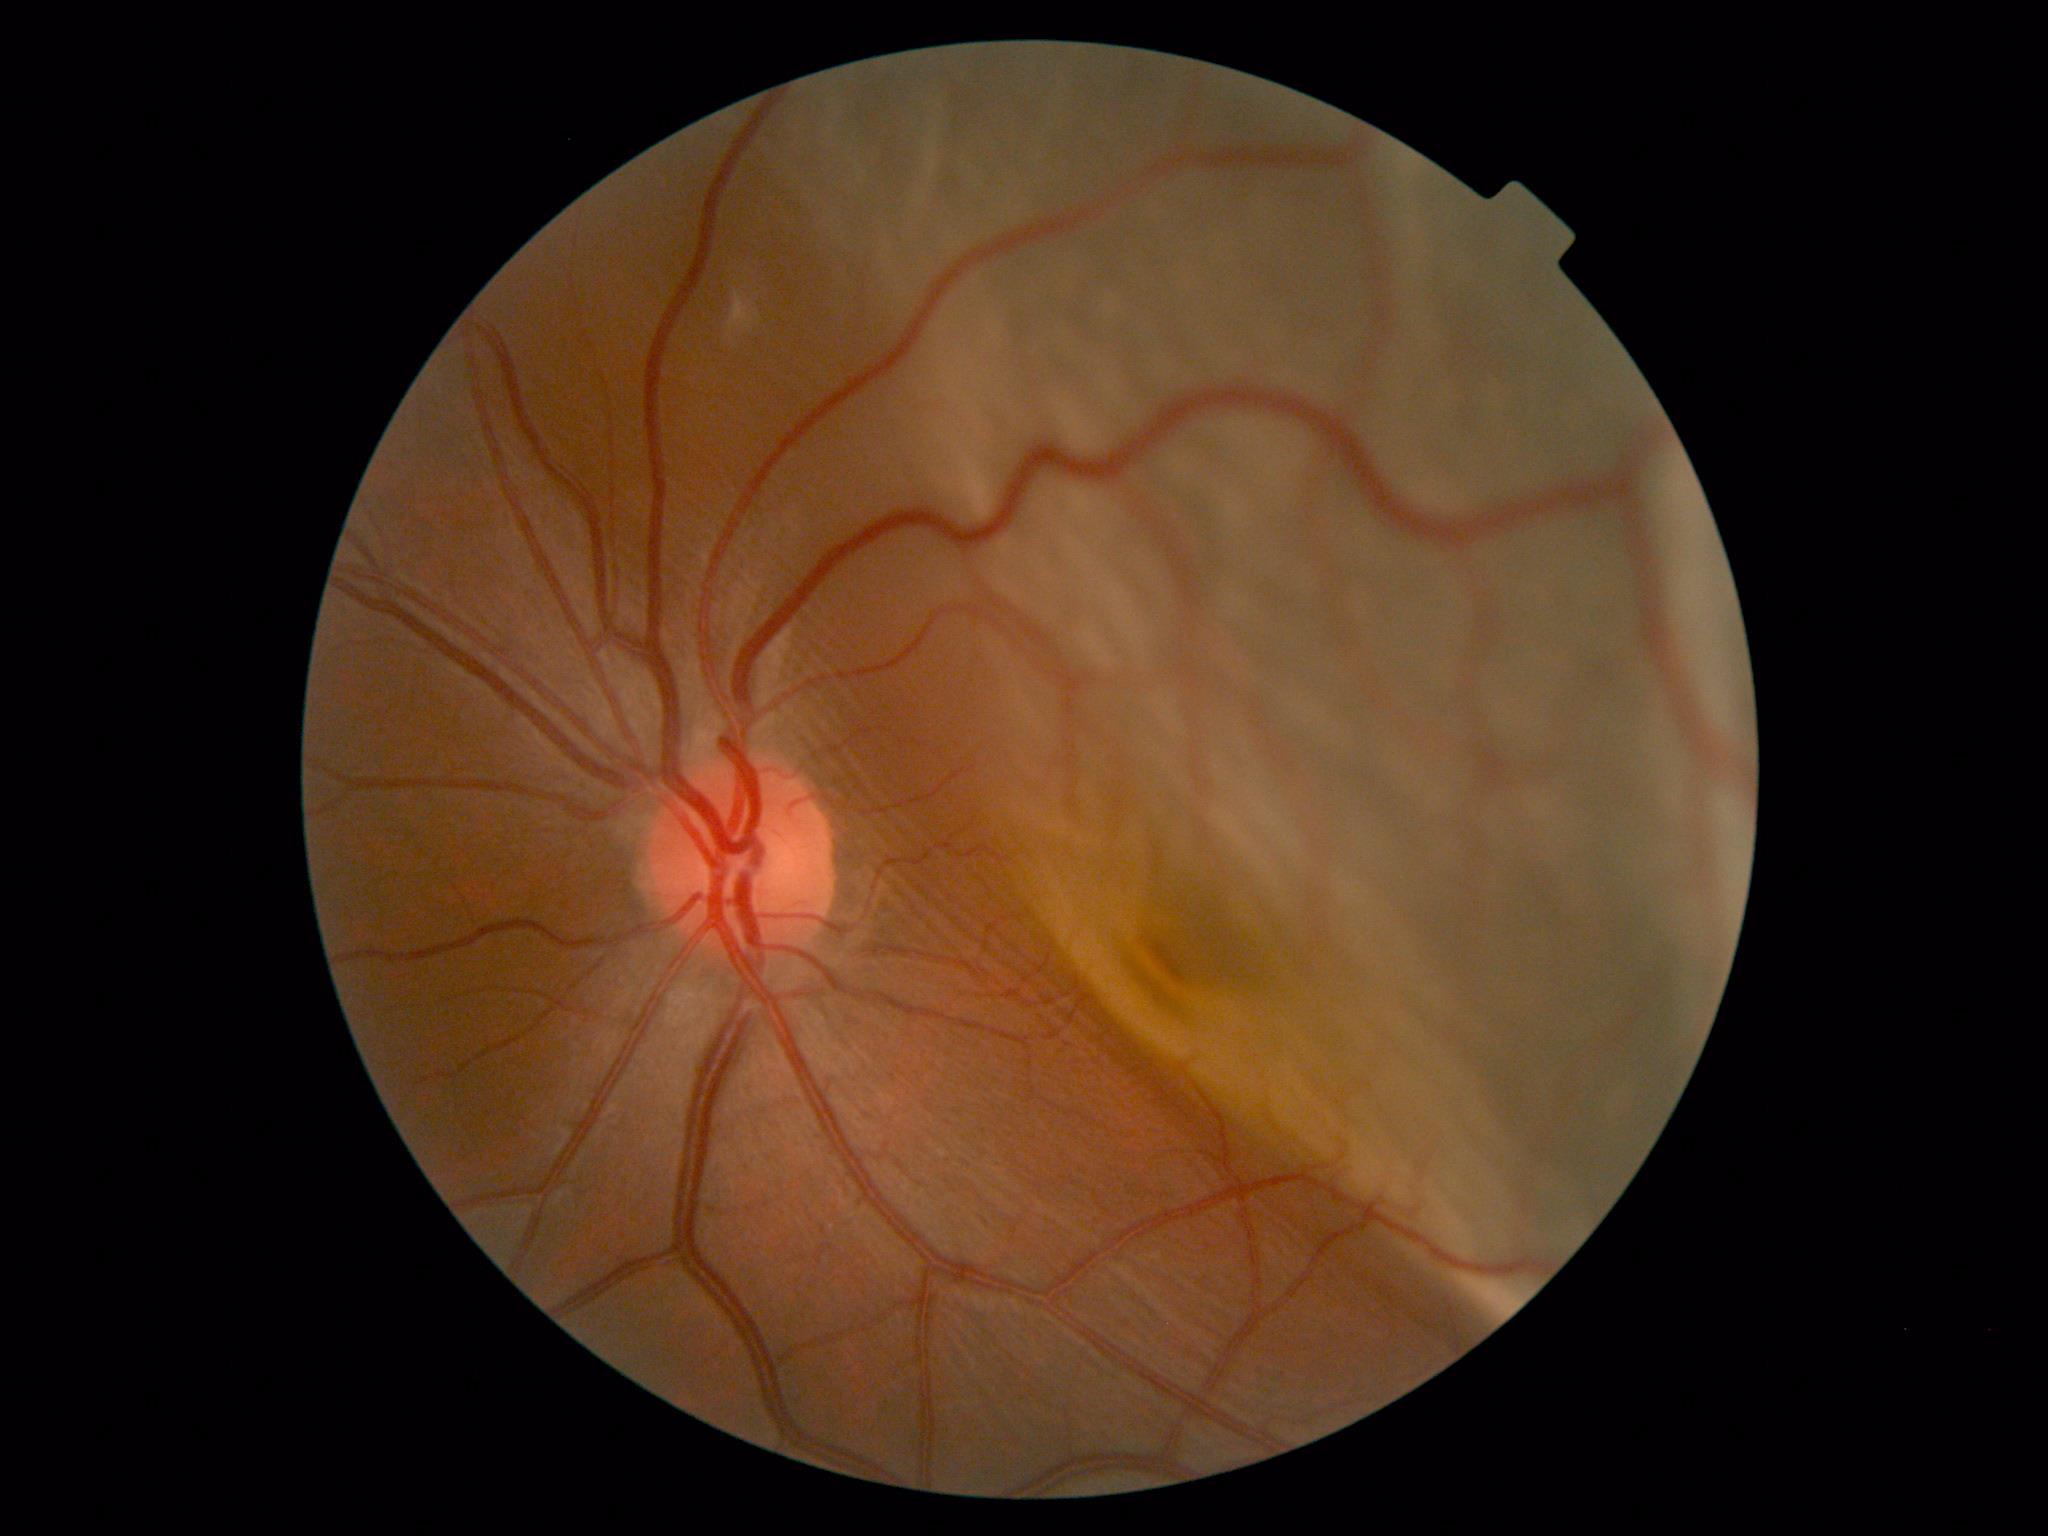

Disease class: proliferative diabetic retinopathy.
DR: PDR (grade 4) — neovascularization and/or vitreous/pre-retinal hemorrhage.